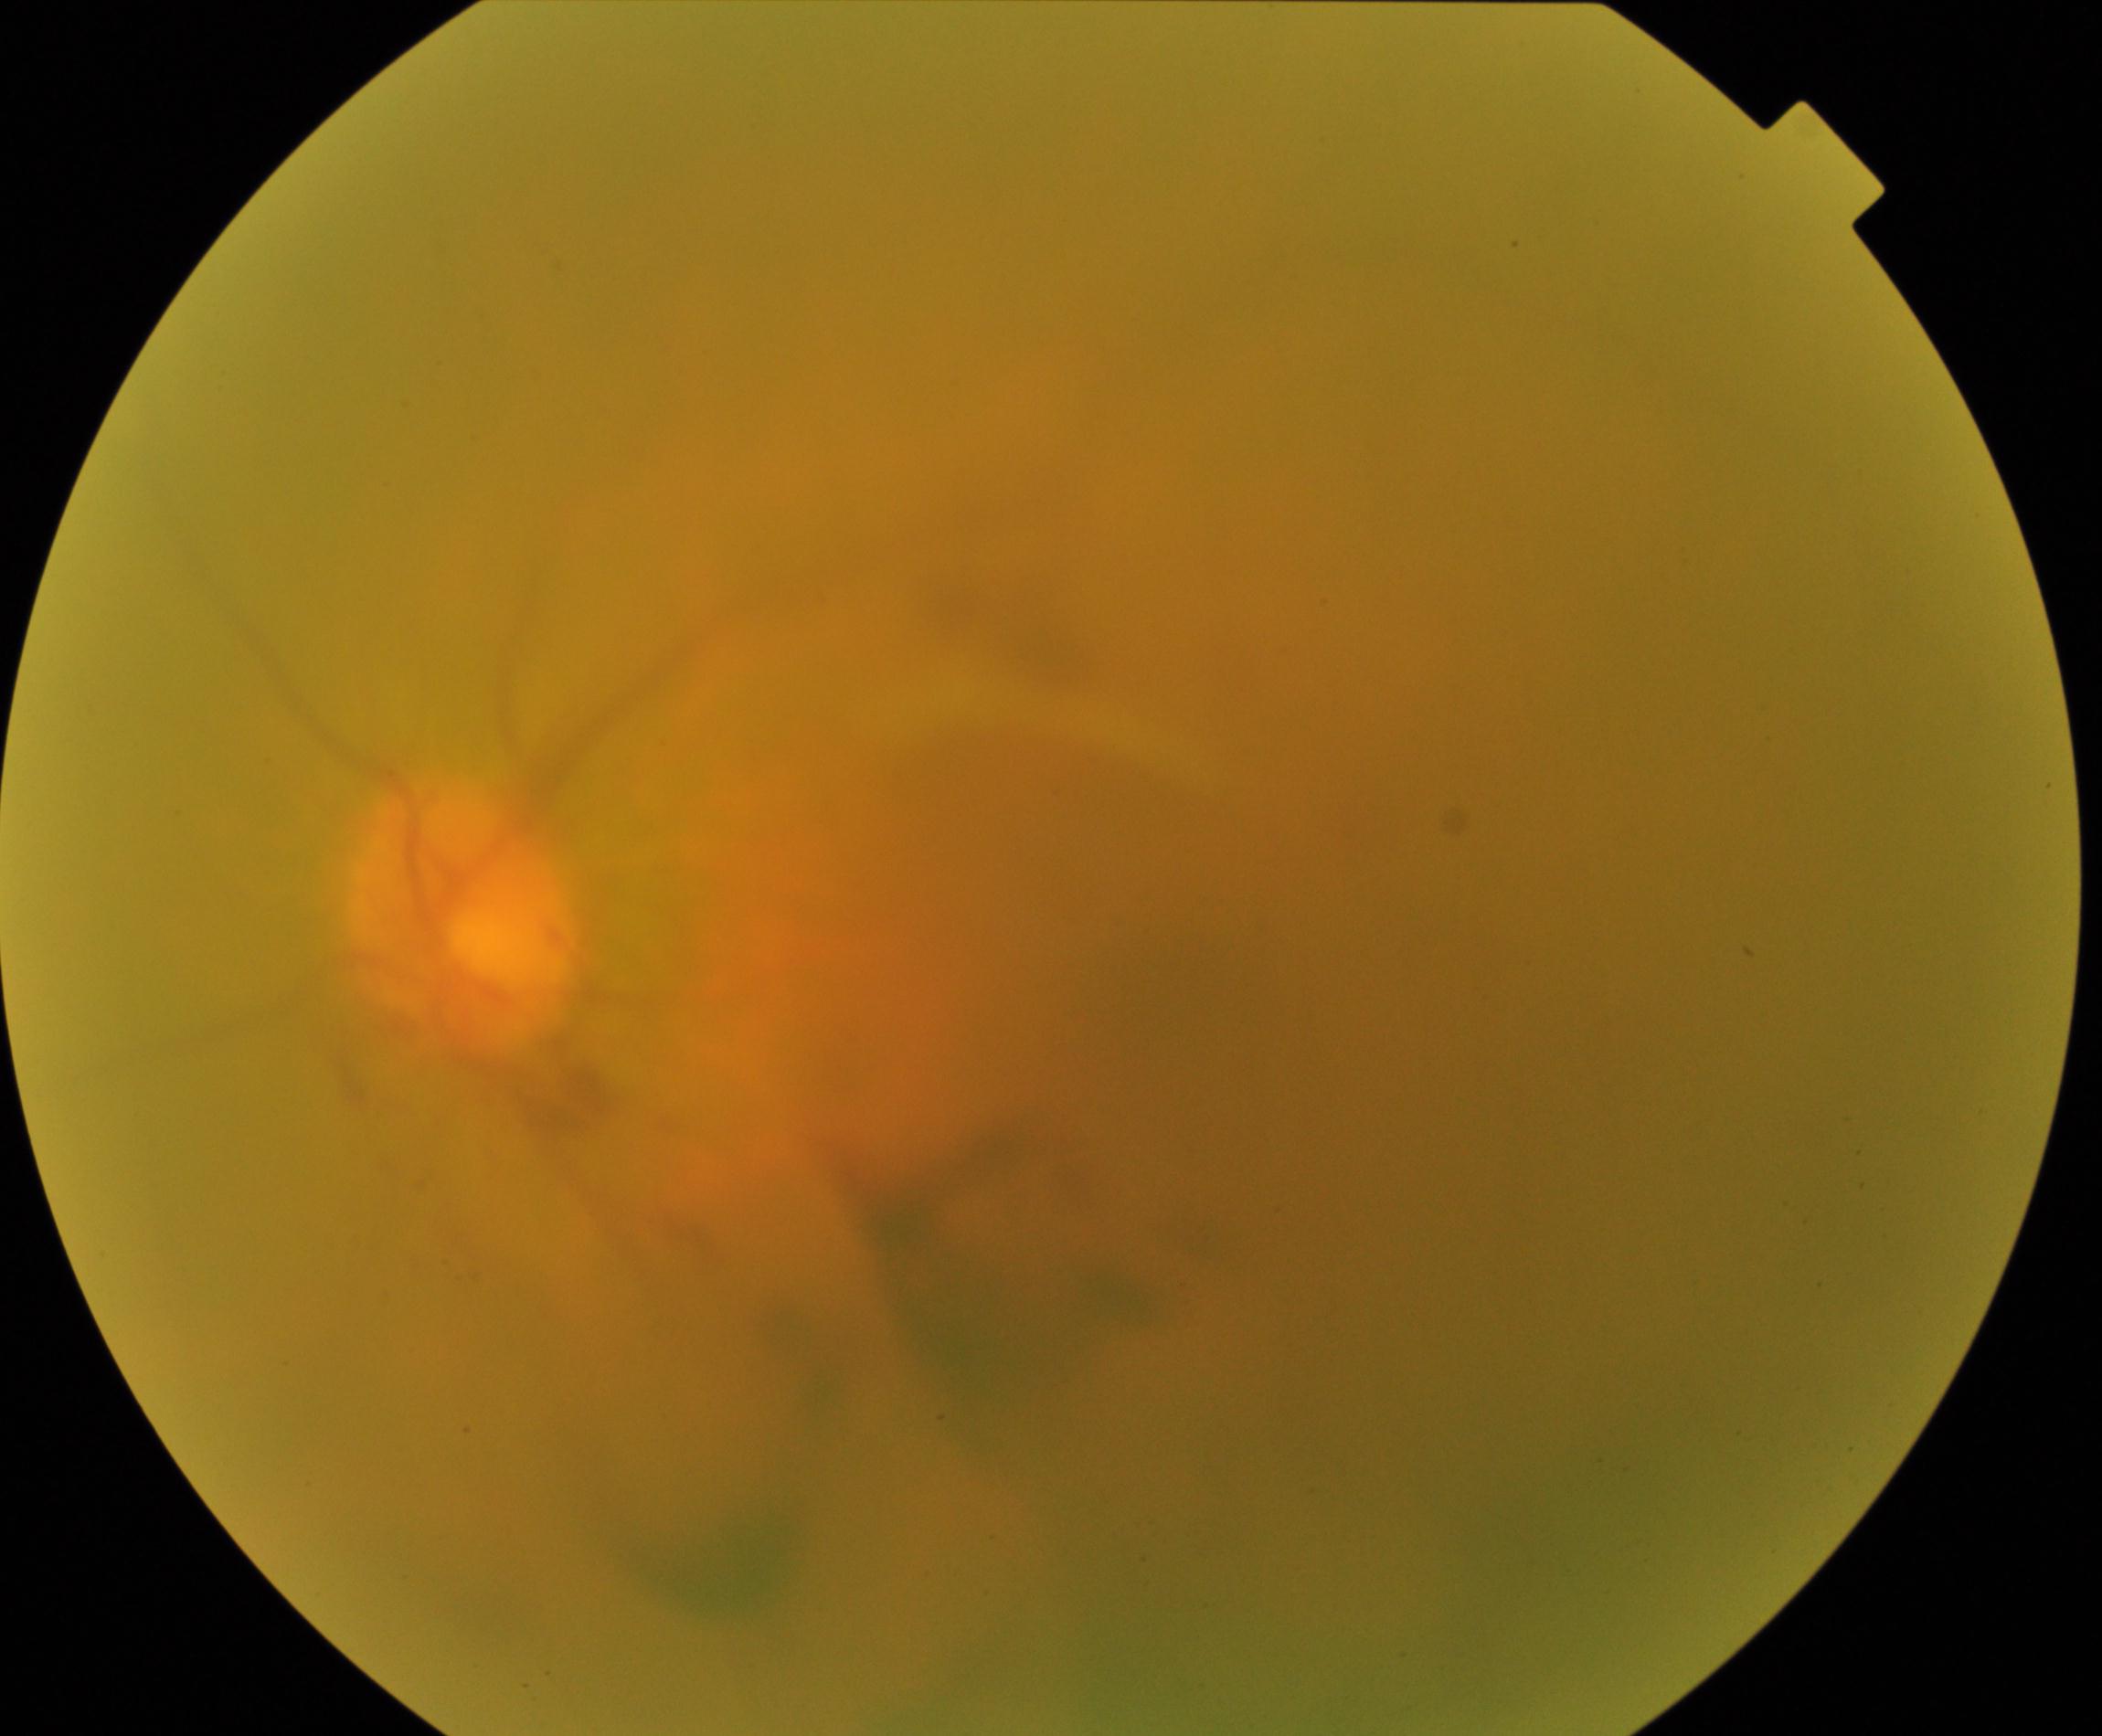
Gradability: poor. Proliferative retinopathy: suspected, not confirmed.